Image size 2352x1568; 45° FOV: 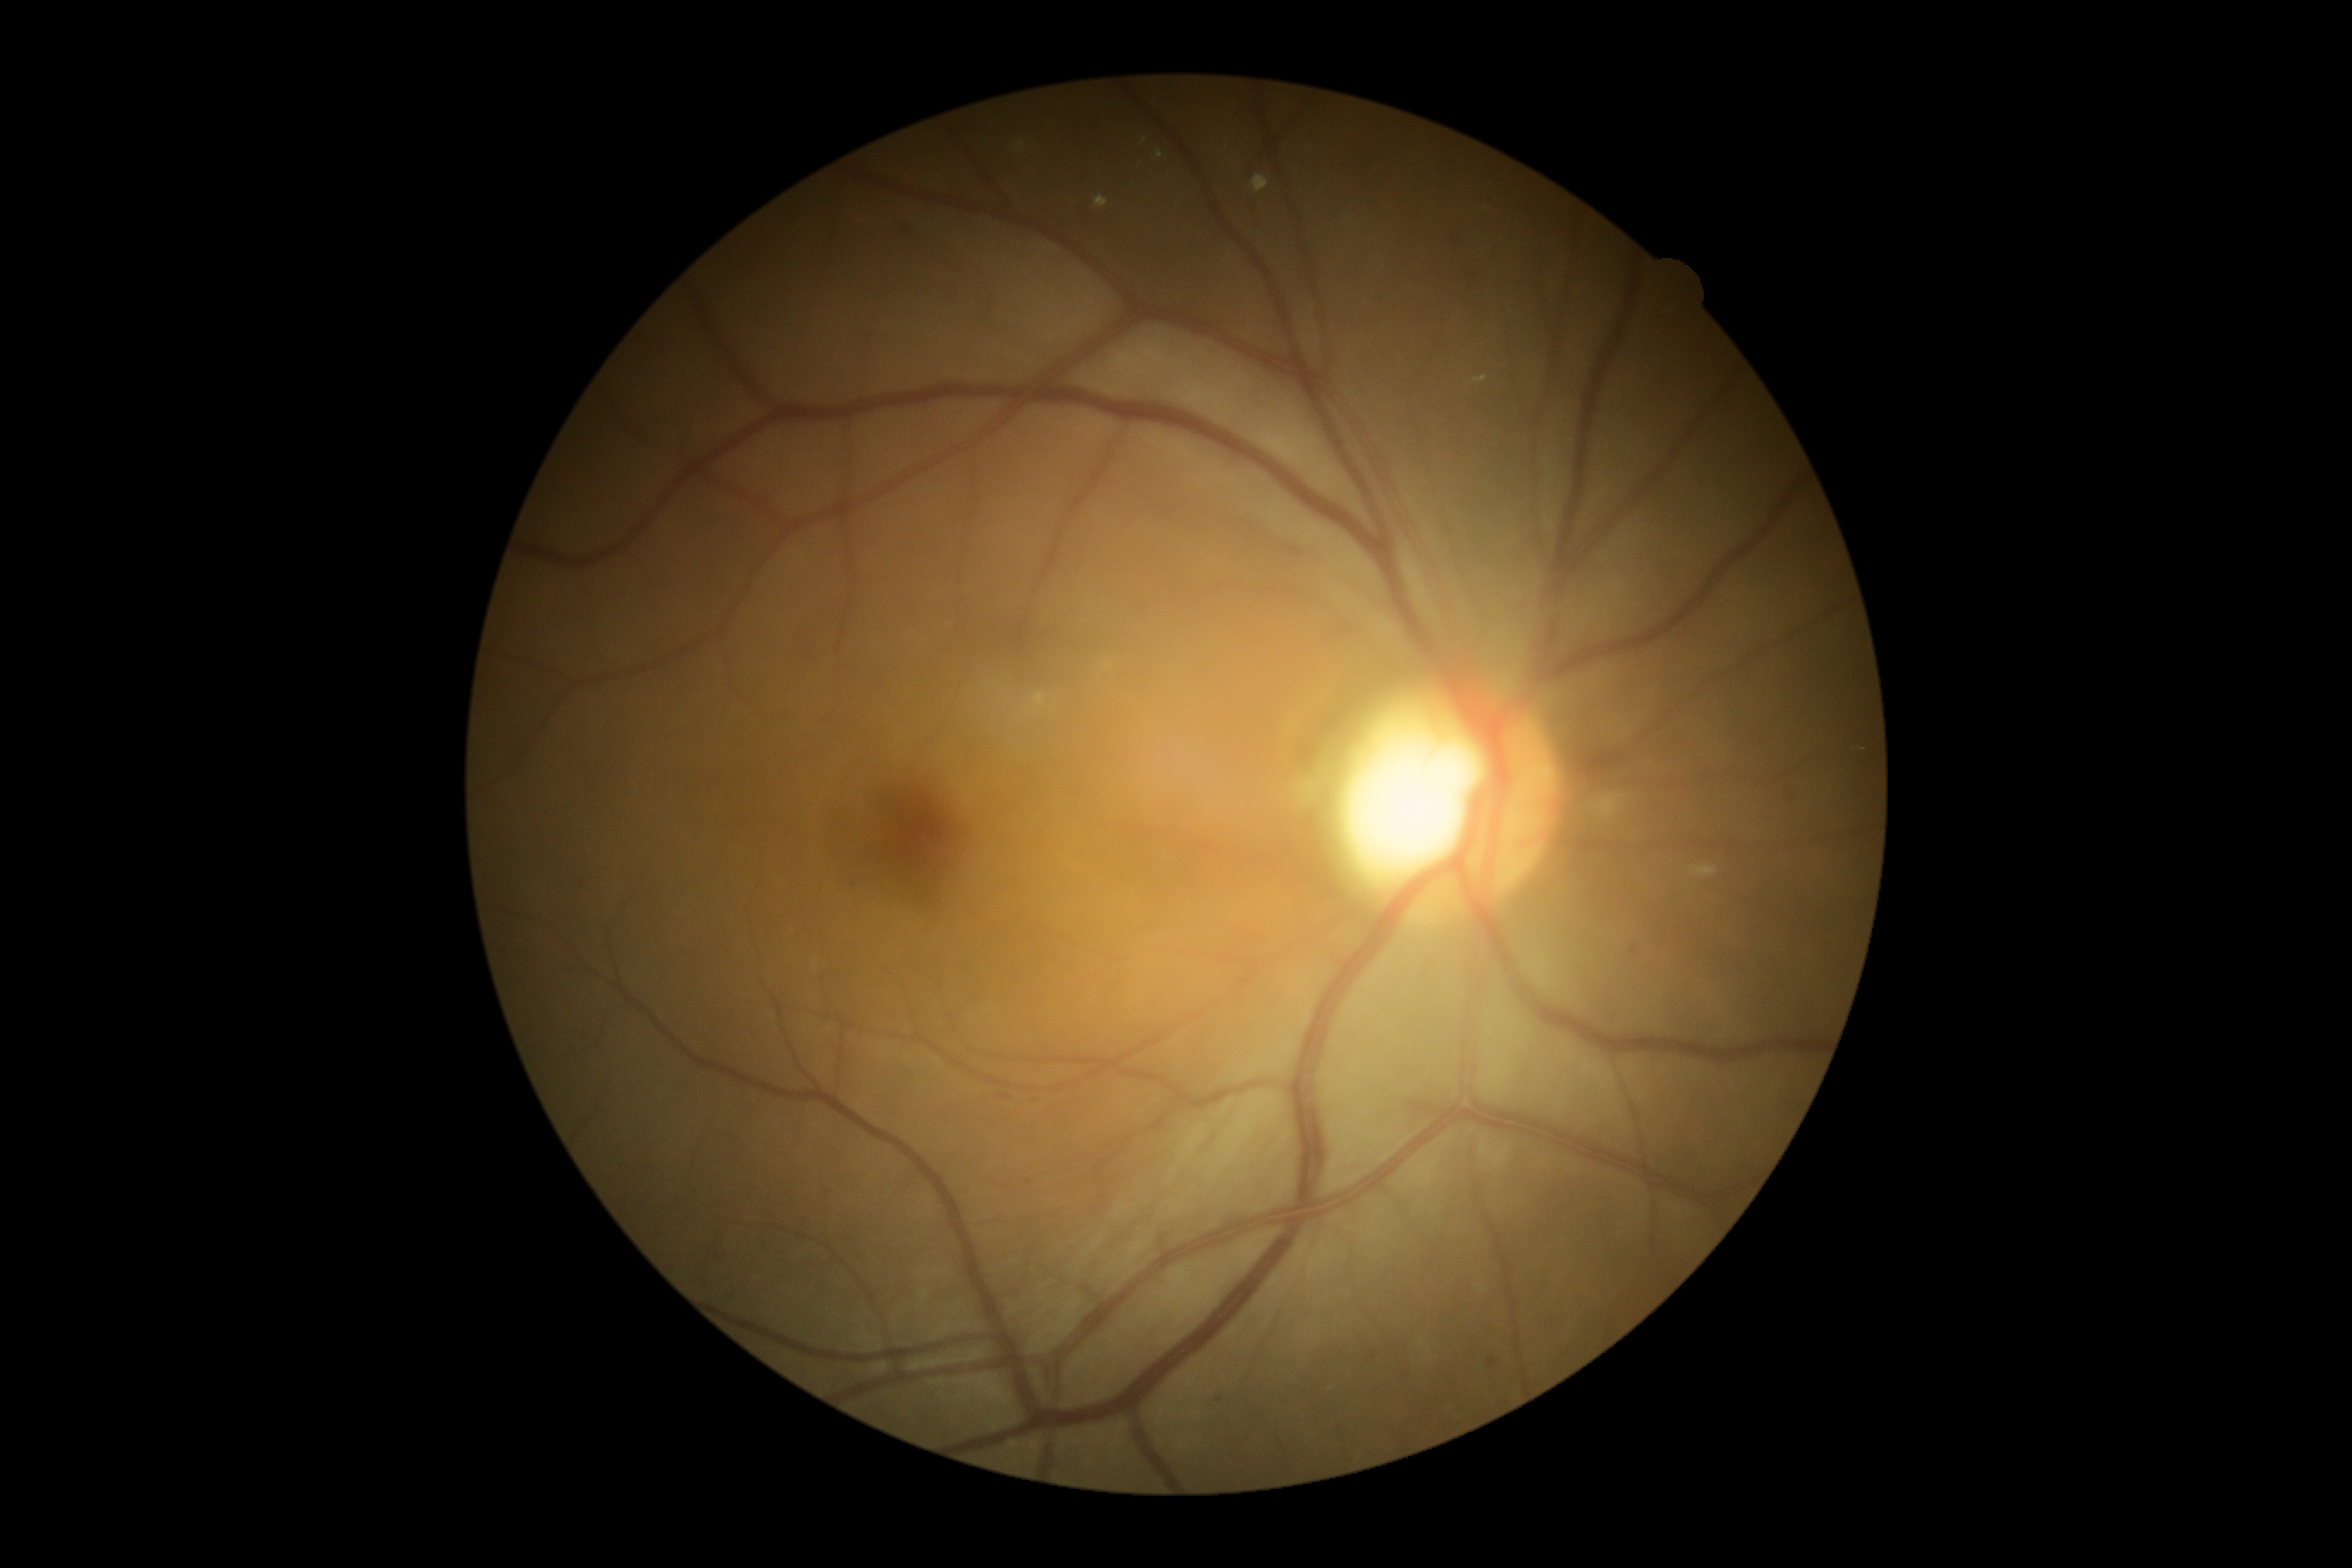
diabetic retinopathy (DR) = 2.